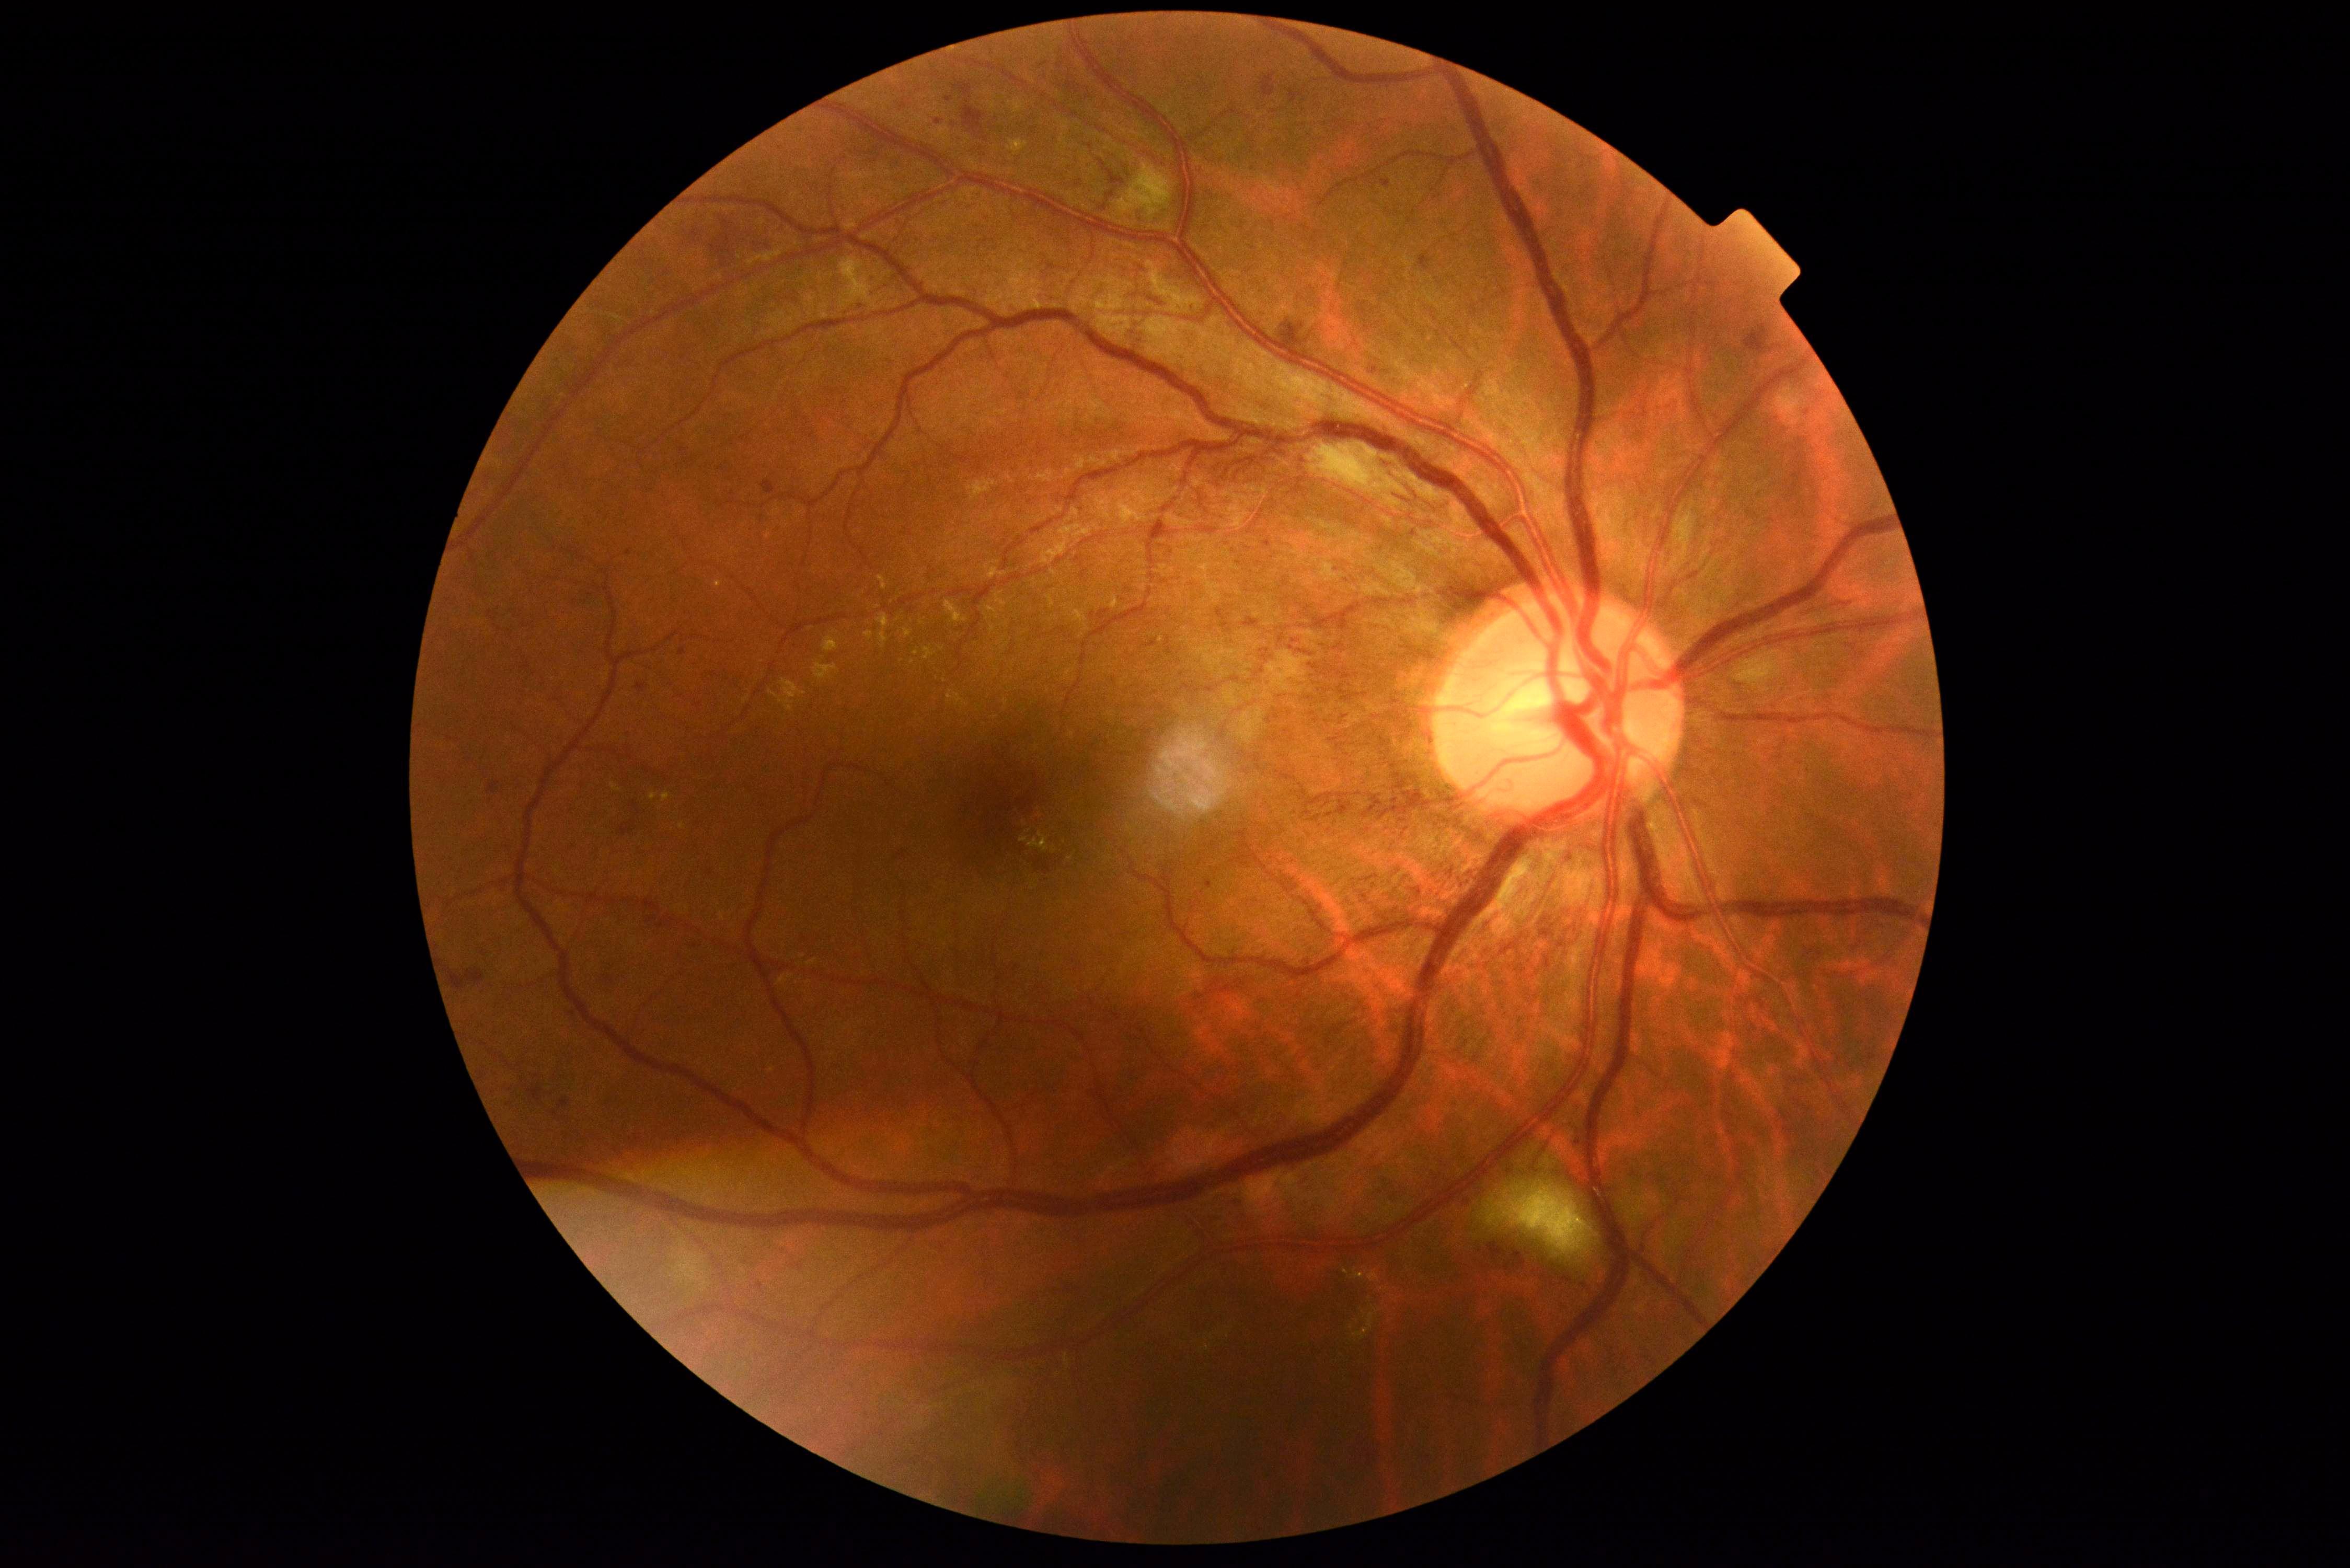 Annotations:
• DR stage — 3/4